1932 x 1932 pixels
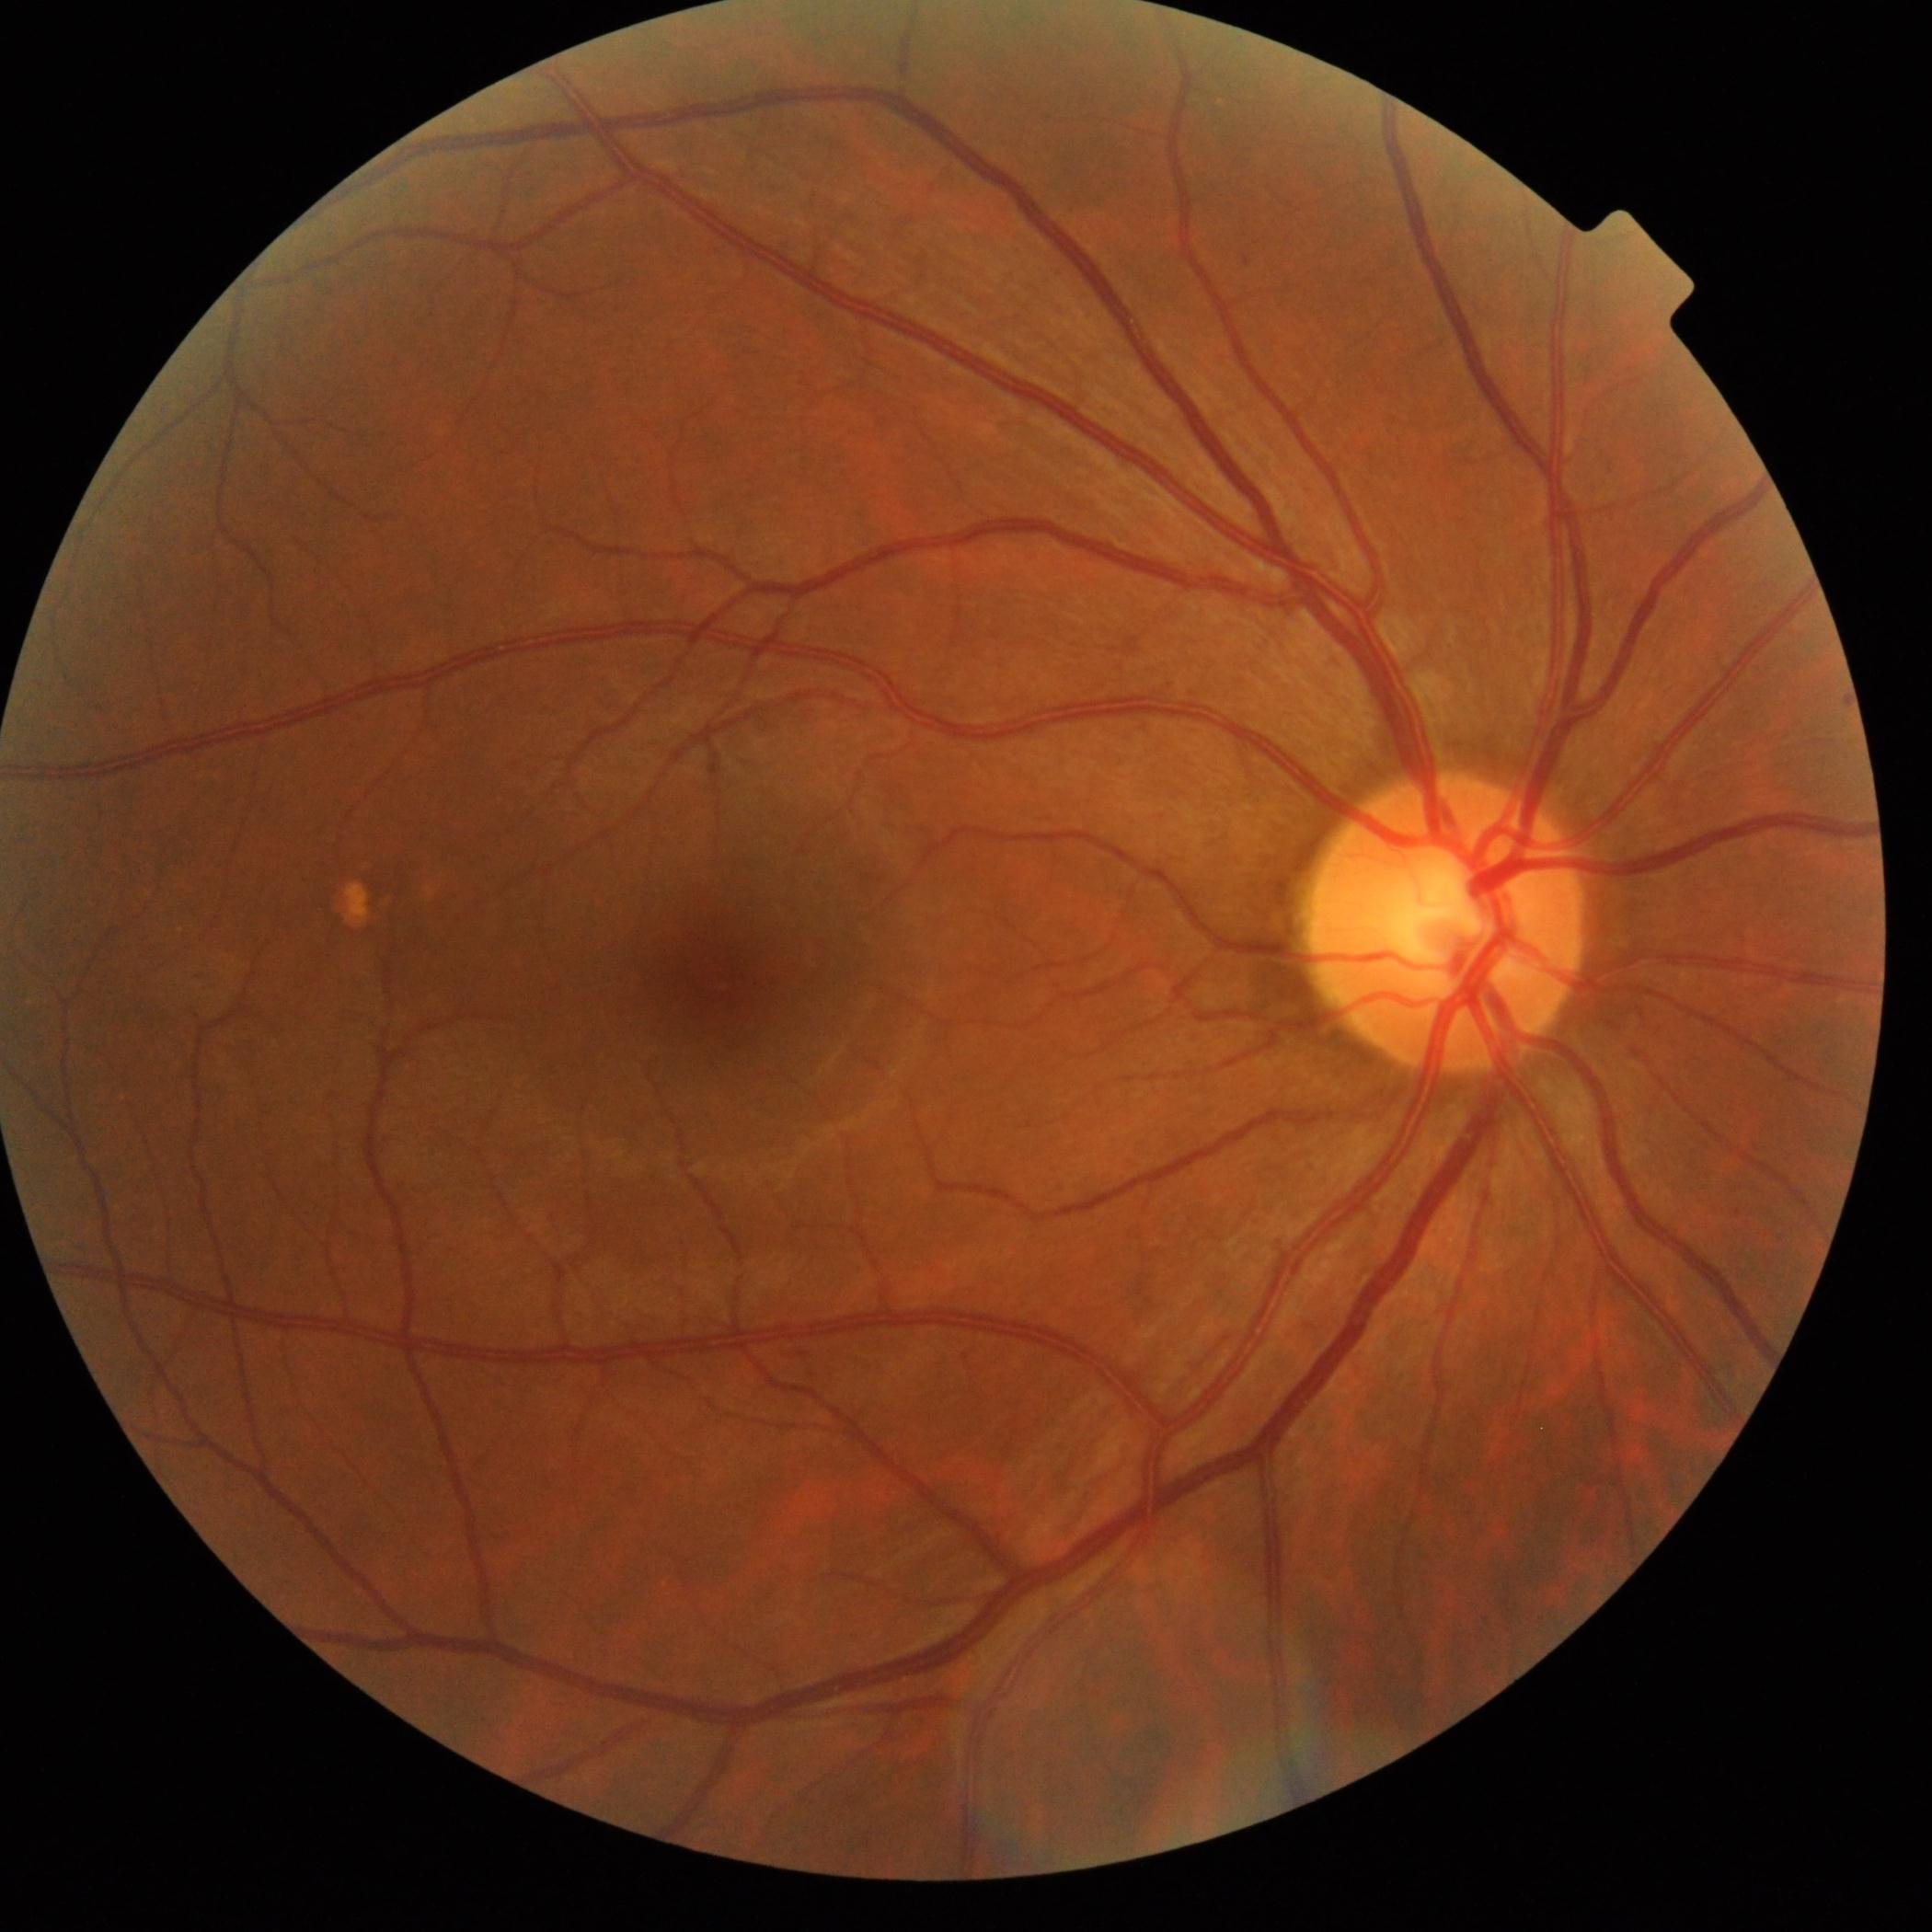

Diabetic retinopathy grade is 1.